Phoenix ICON, 100° FOV · wide-field fundus photograph from neonatal ROP screening — 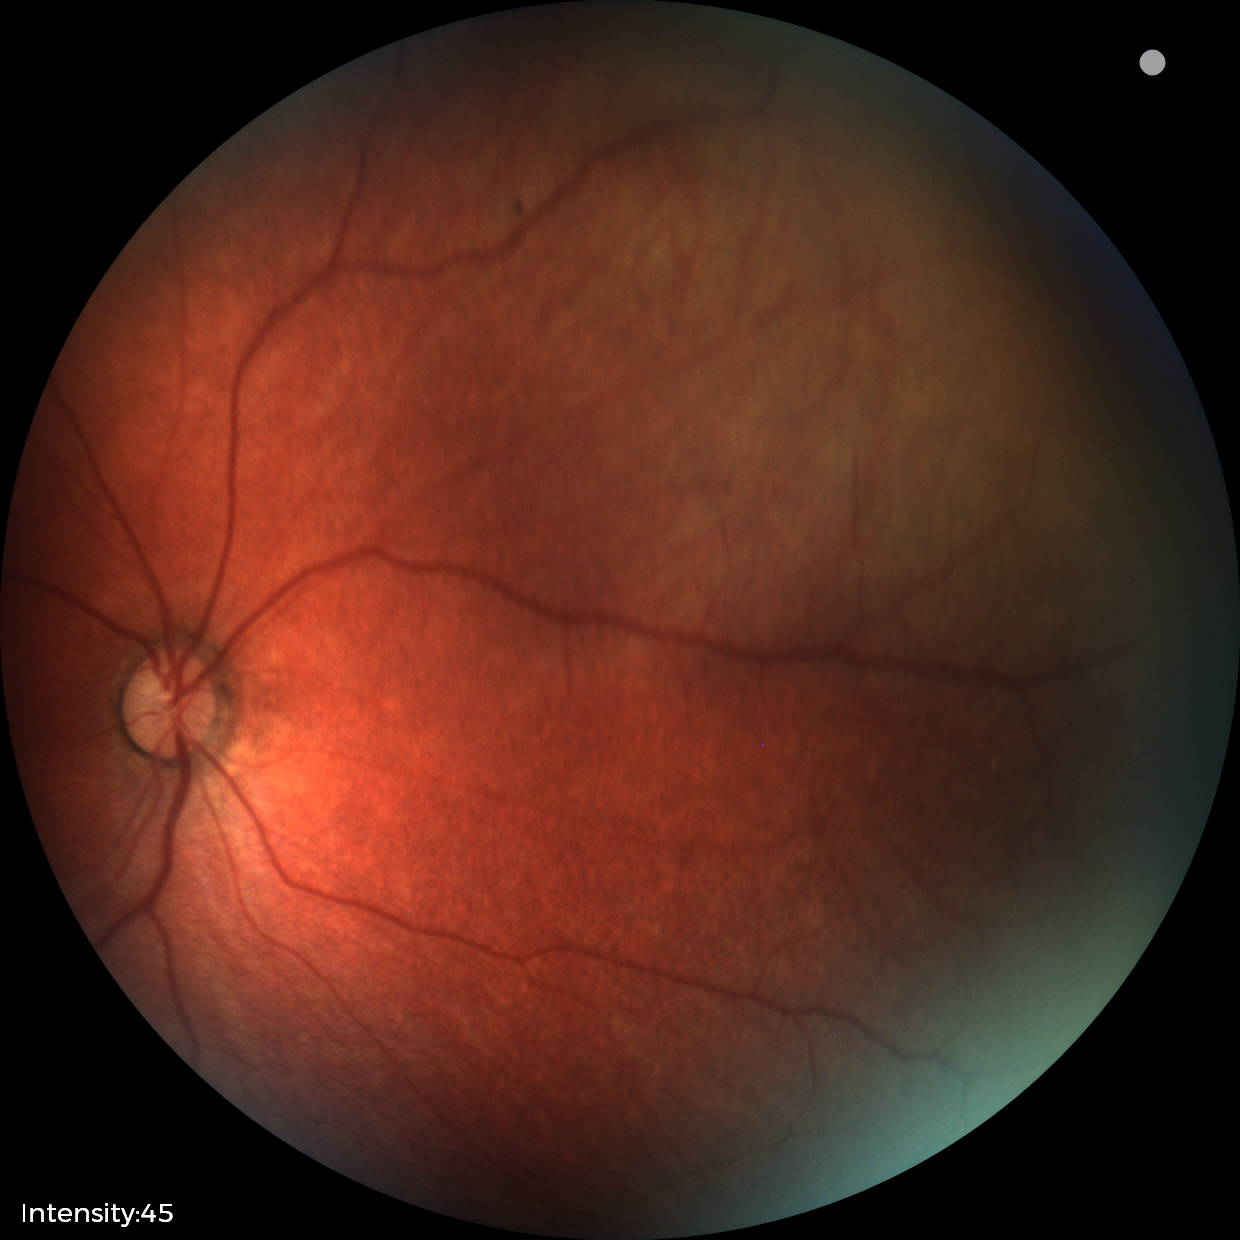
Screening examination with no abnormal retinal findings.